Captured with the Phoenix ICON (100° field of view) · 1240x1240 · wide-field contact fundus photograph of an infant:
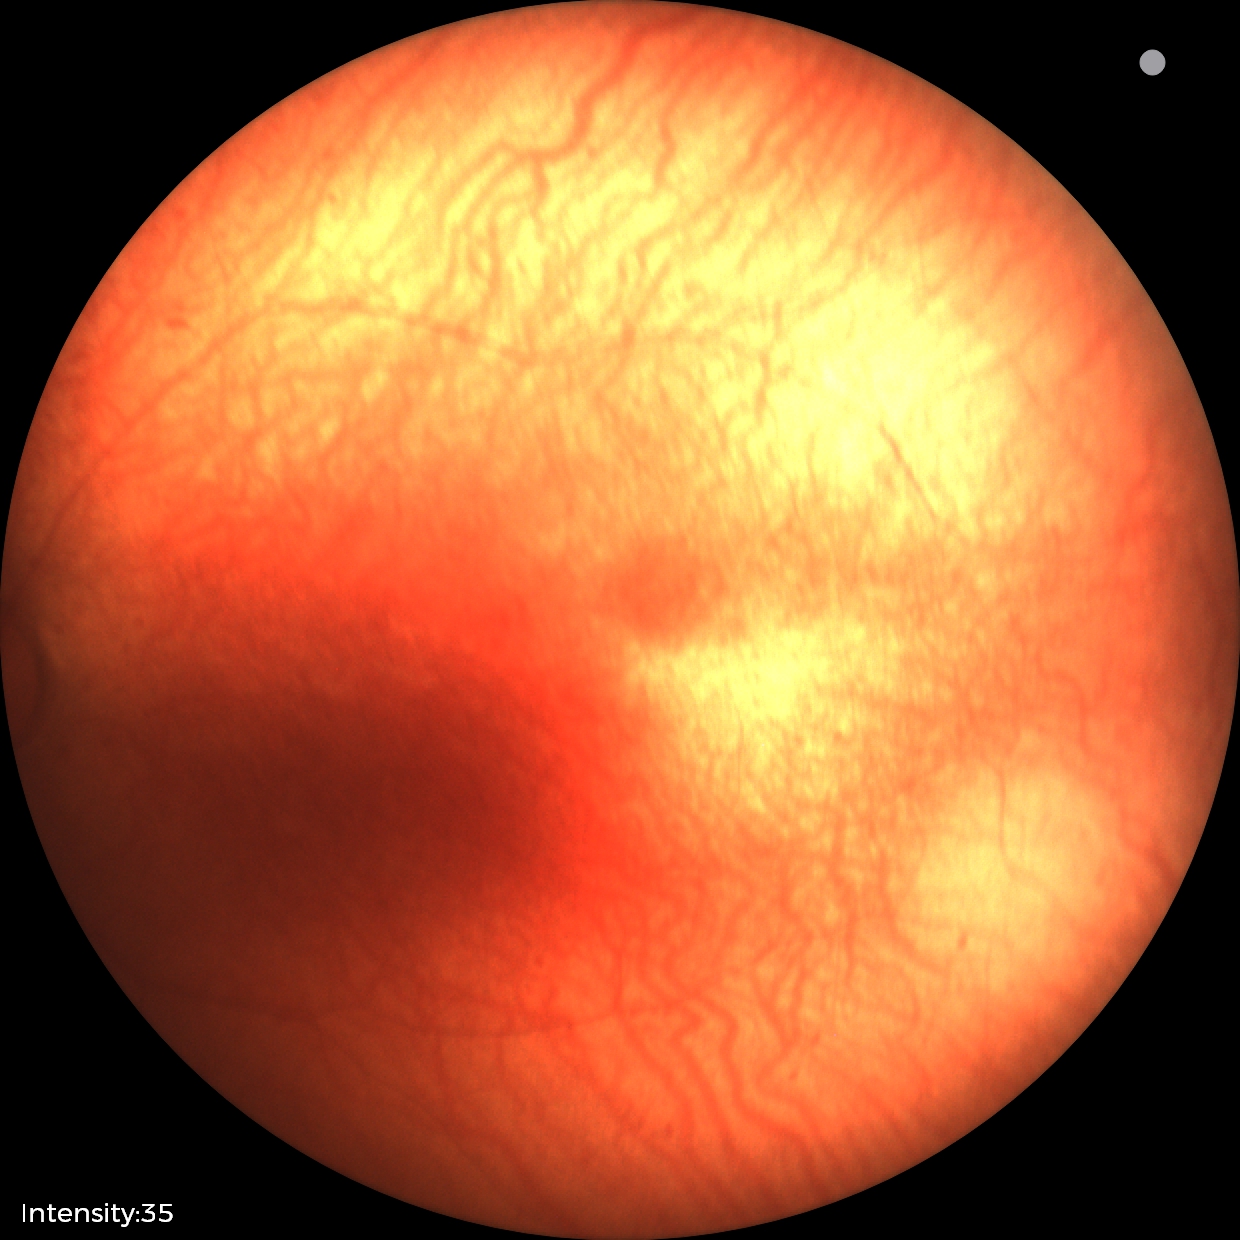
Impression: normal retinal appearance.